Image size 640x480. Wide-field fundus photograph from neonatal ROP screening:
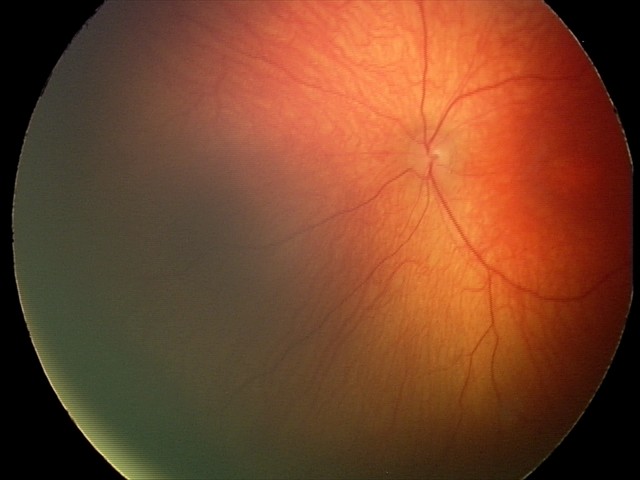

Q: What is the screening diagnosis?
A: physiological finding